Pediatric wide-field fundus photograph · camera: Natus RetCam Envision (130° FOV)
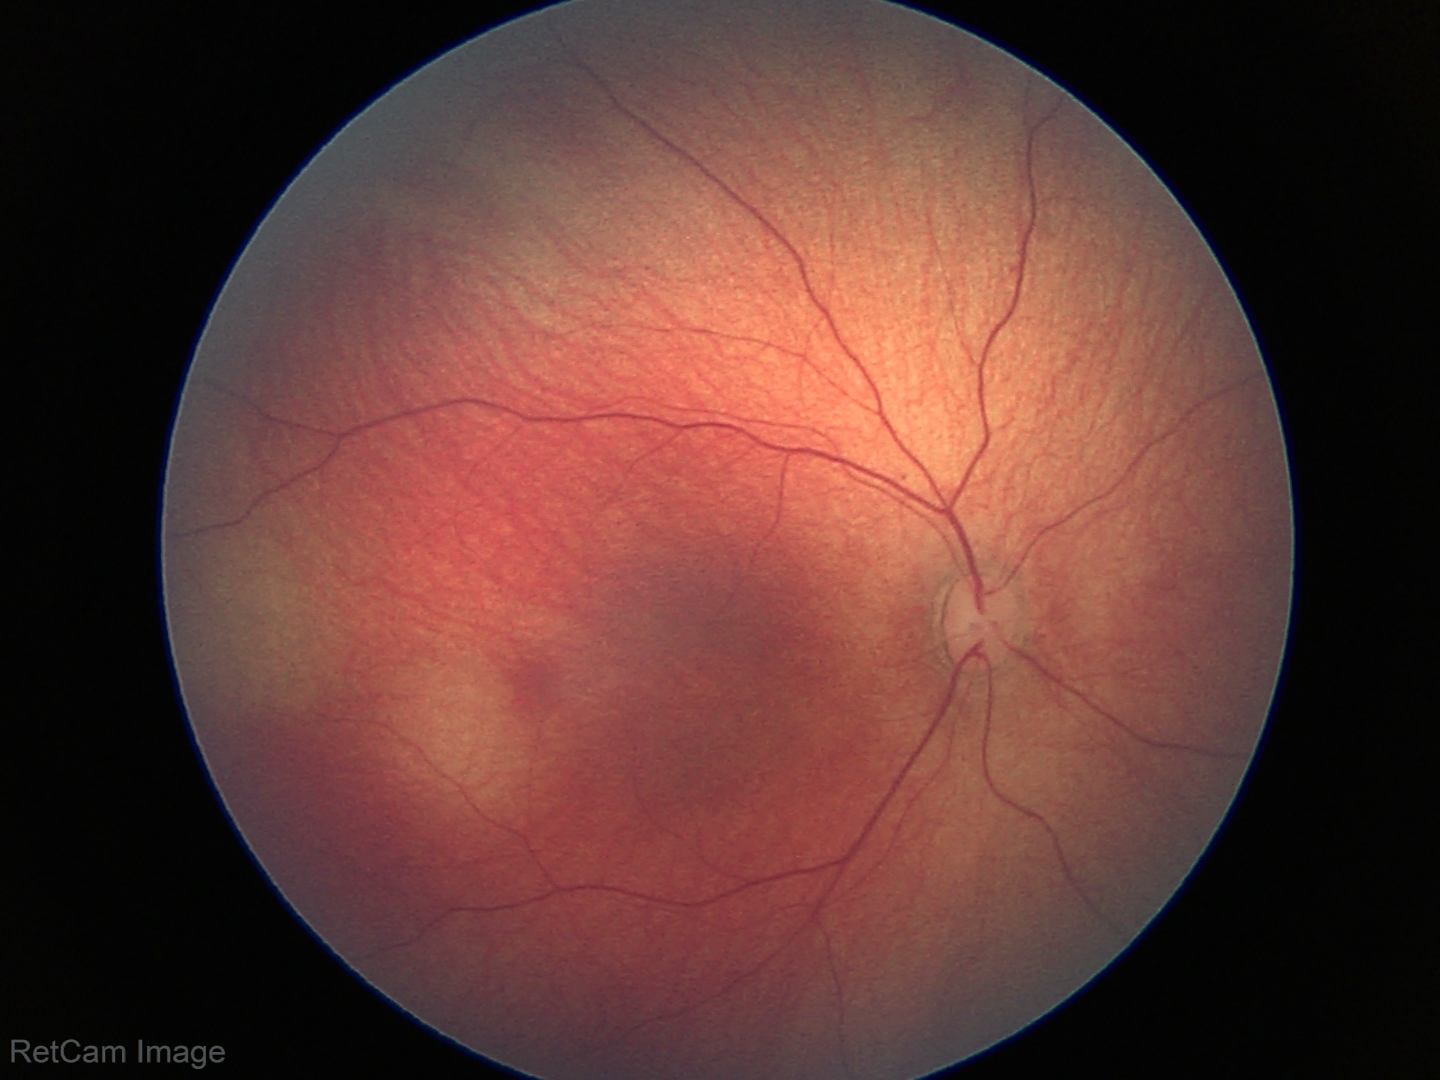 No retinal pathology identified on screening.